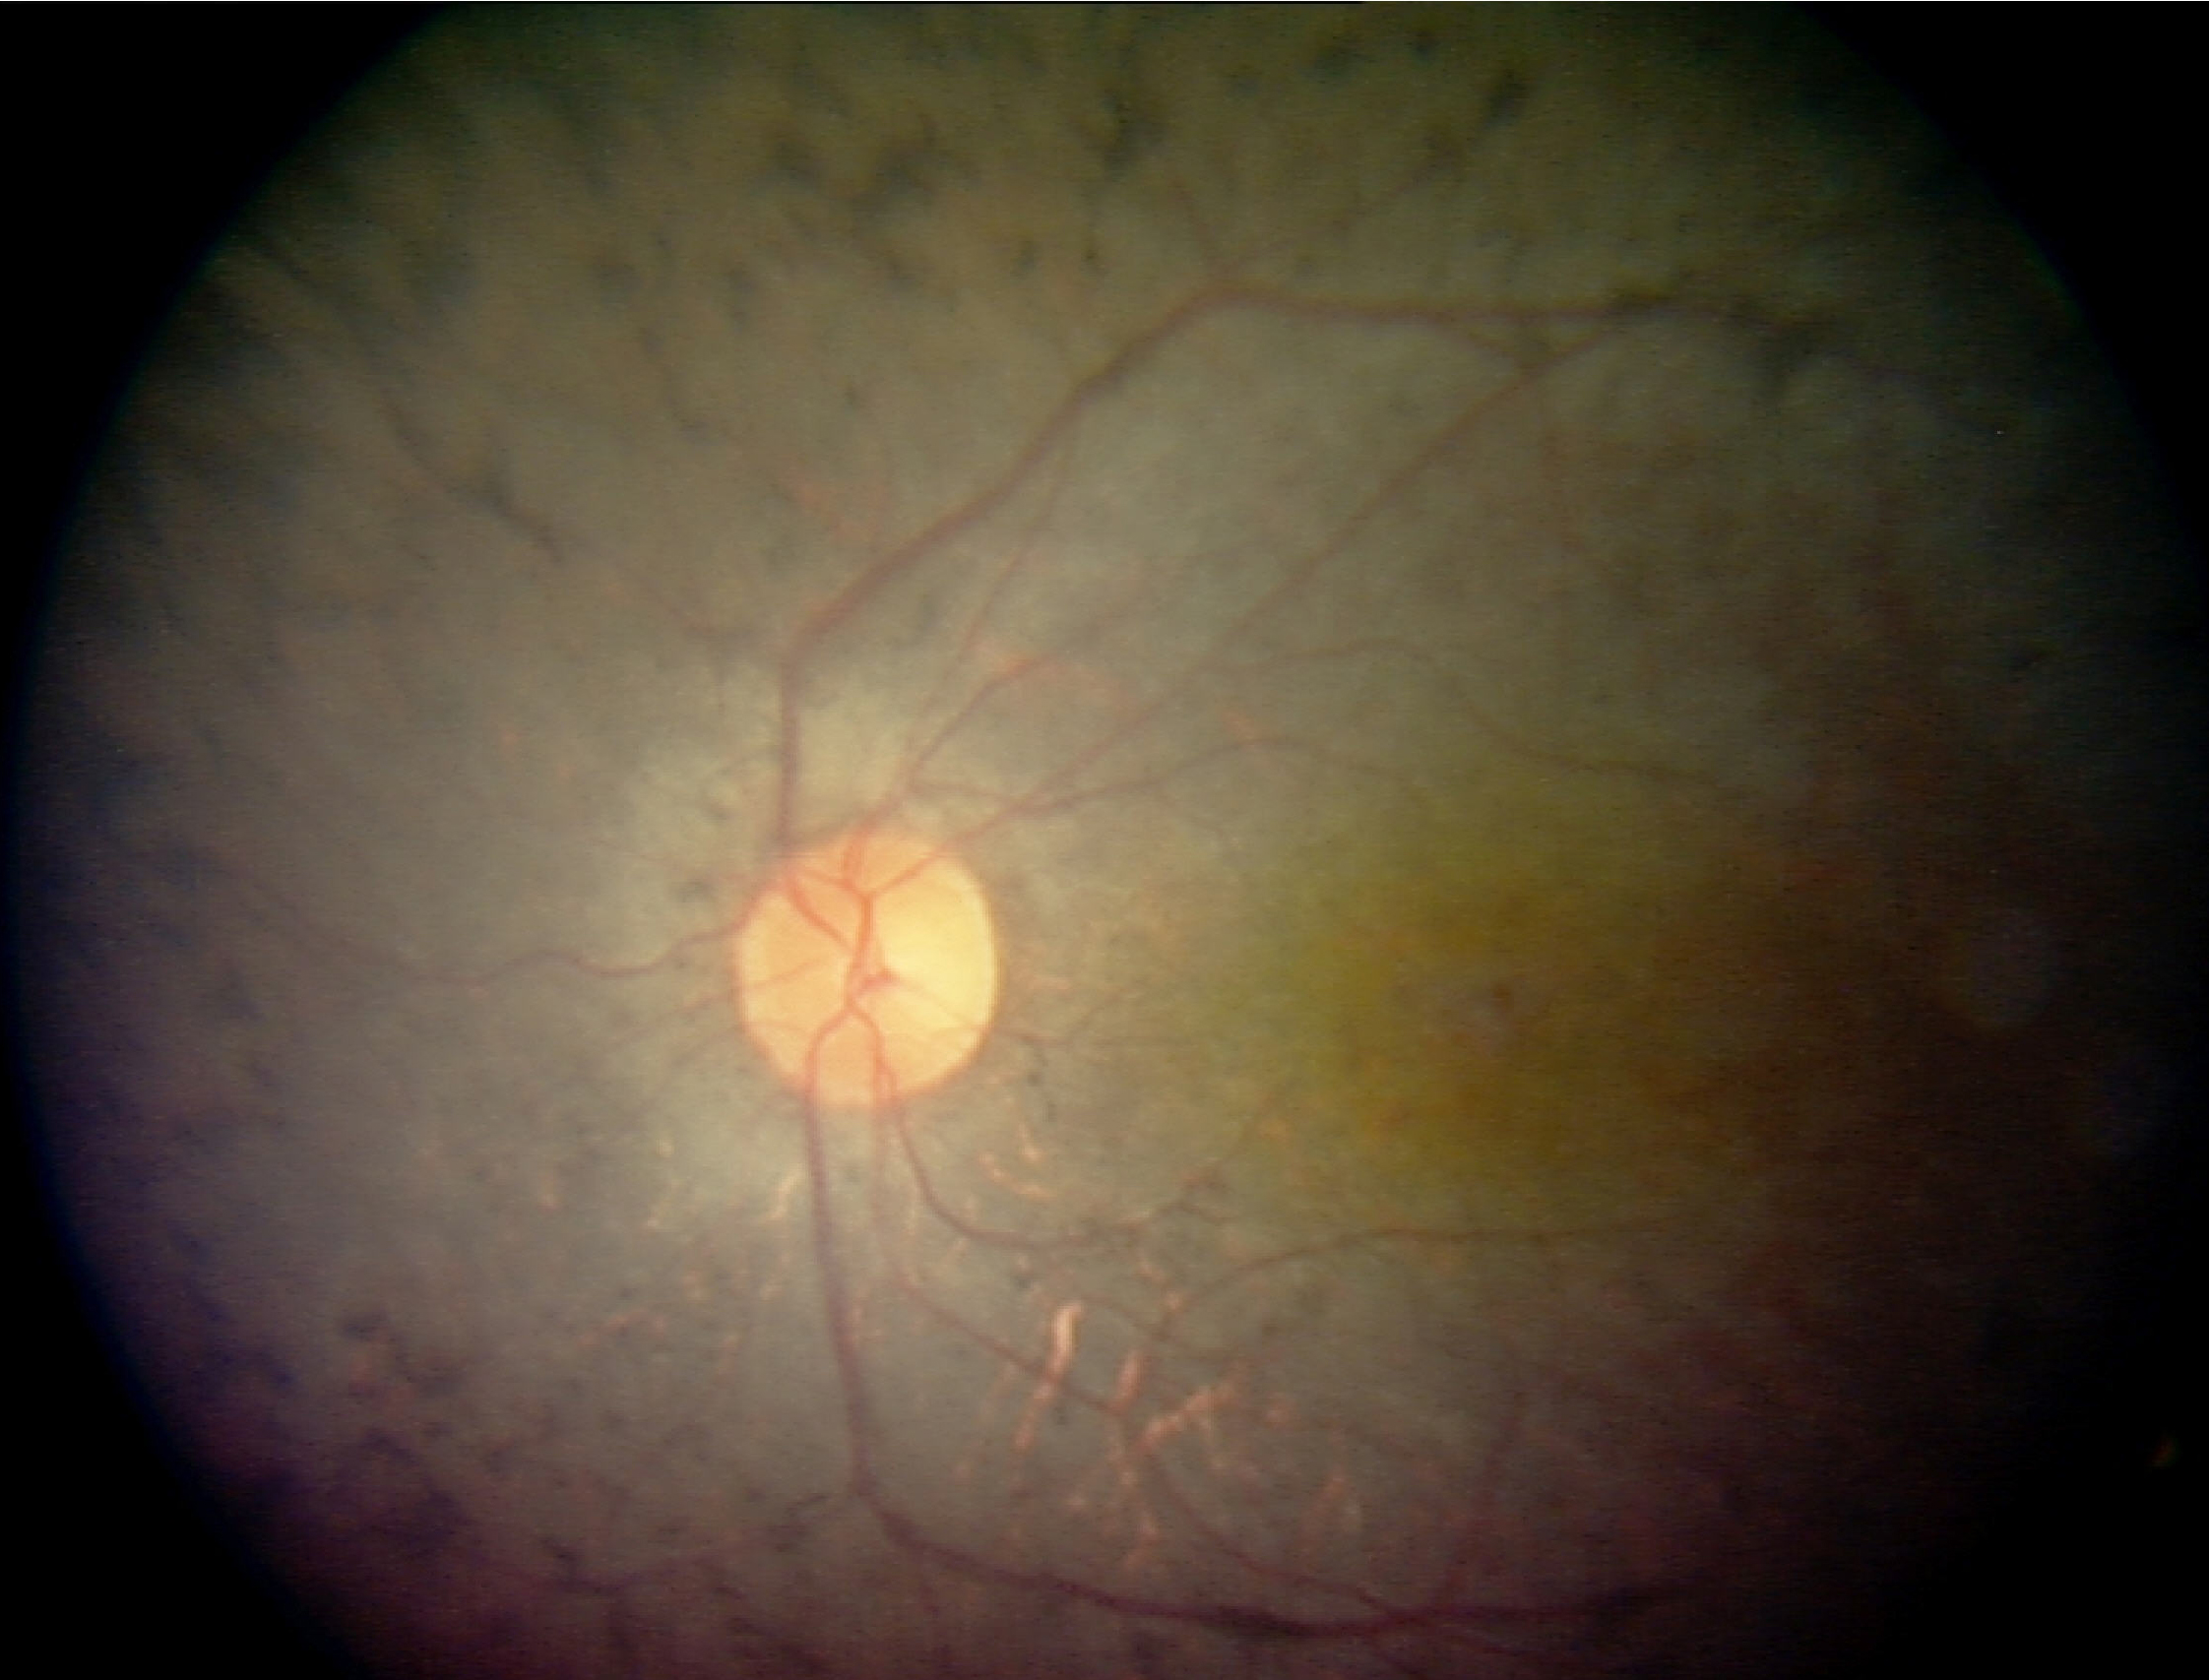

Primary finding: retinitis pigmentosa.